Pediatric wide-field fundus photograph; camera: Clarity RetCam 3 (130° FOV): 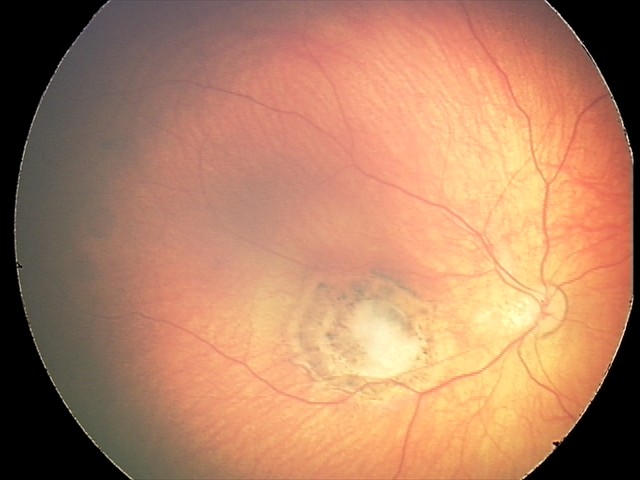
Screening examination consistent with toxoplasmosis chorioretinitis.